Image size 1659x2212 · fundus photo: 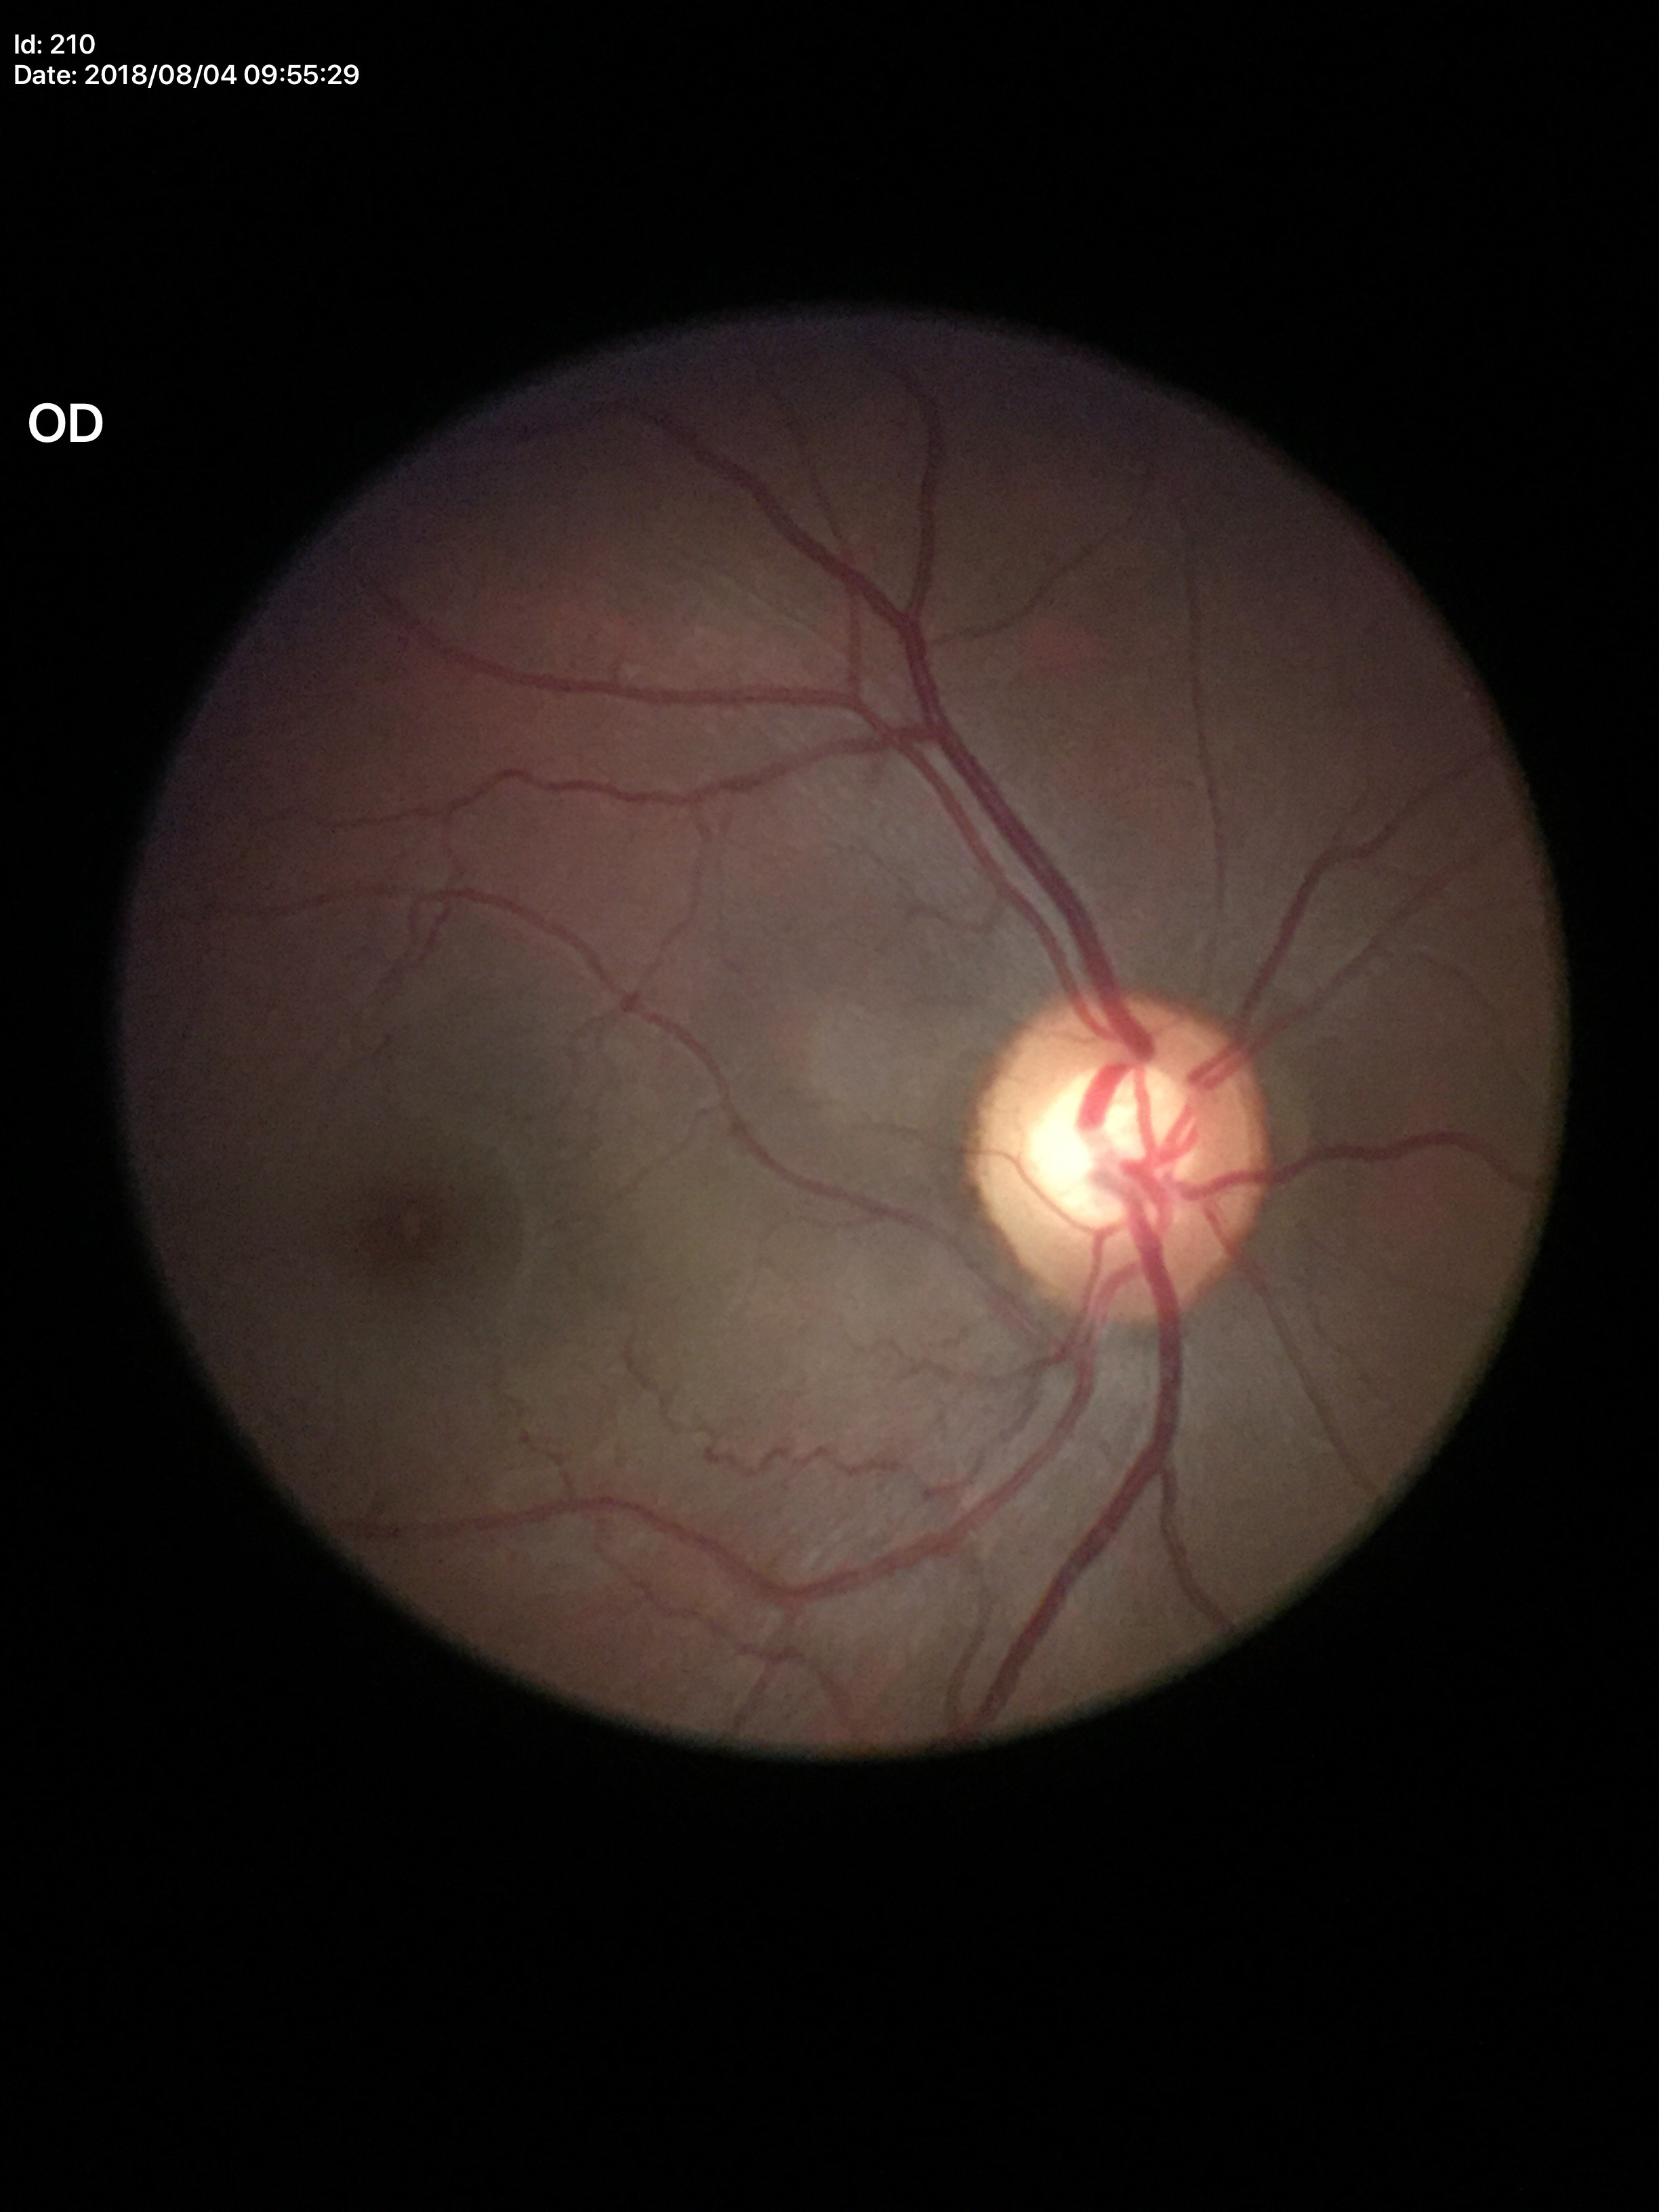

Q: Vertical CDR?
A: 0.61
Q: What is the HCDR?
A: 0.65
Q: Glaucoma screening result?
A: suspect